Pediatric retinal photograph (wide-field):
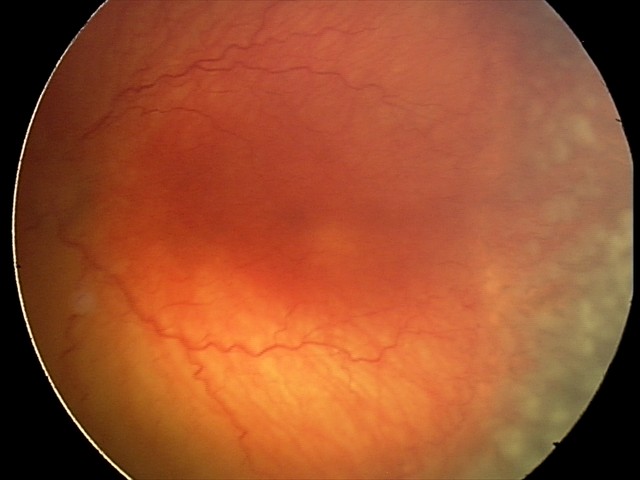
Plus disease present. Examination diagnosed as aggressive ROP (A-ROP).